Wide-field fundus image from infant ROP screening; 130° field of view (Clarity RetCam 3).
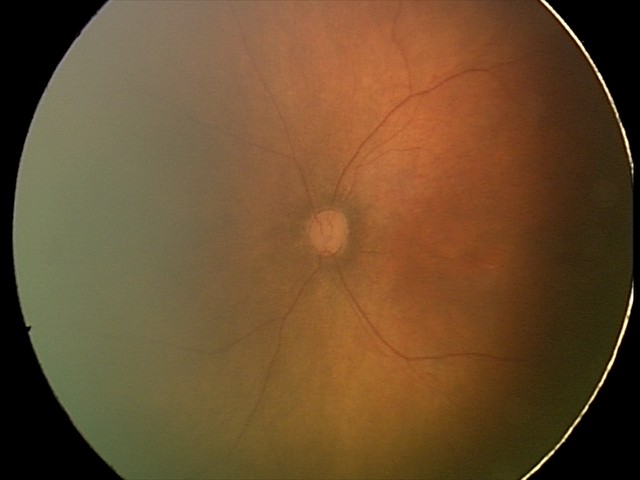 Examination with physiological retinal findings.